Image size 240x240 · CFP.
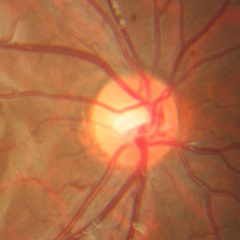
Optic disc appearance consistent with no evidence of glaucoma.